45° FOV.
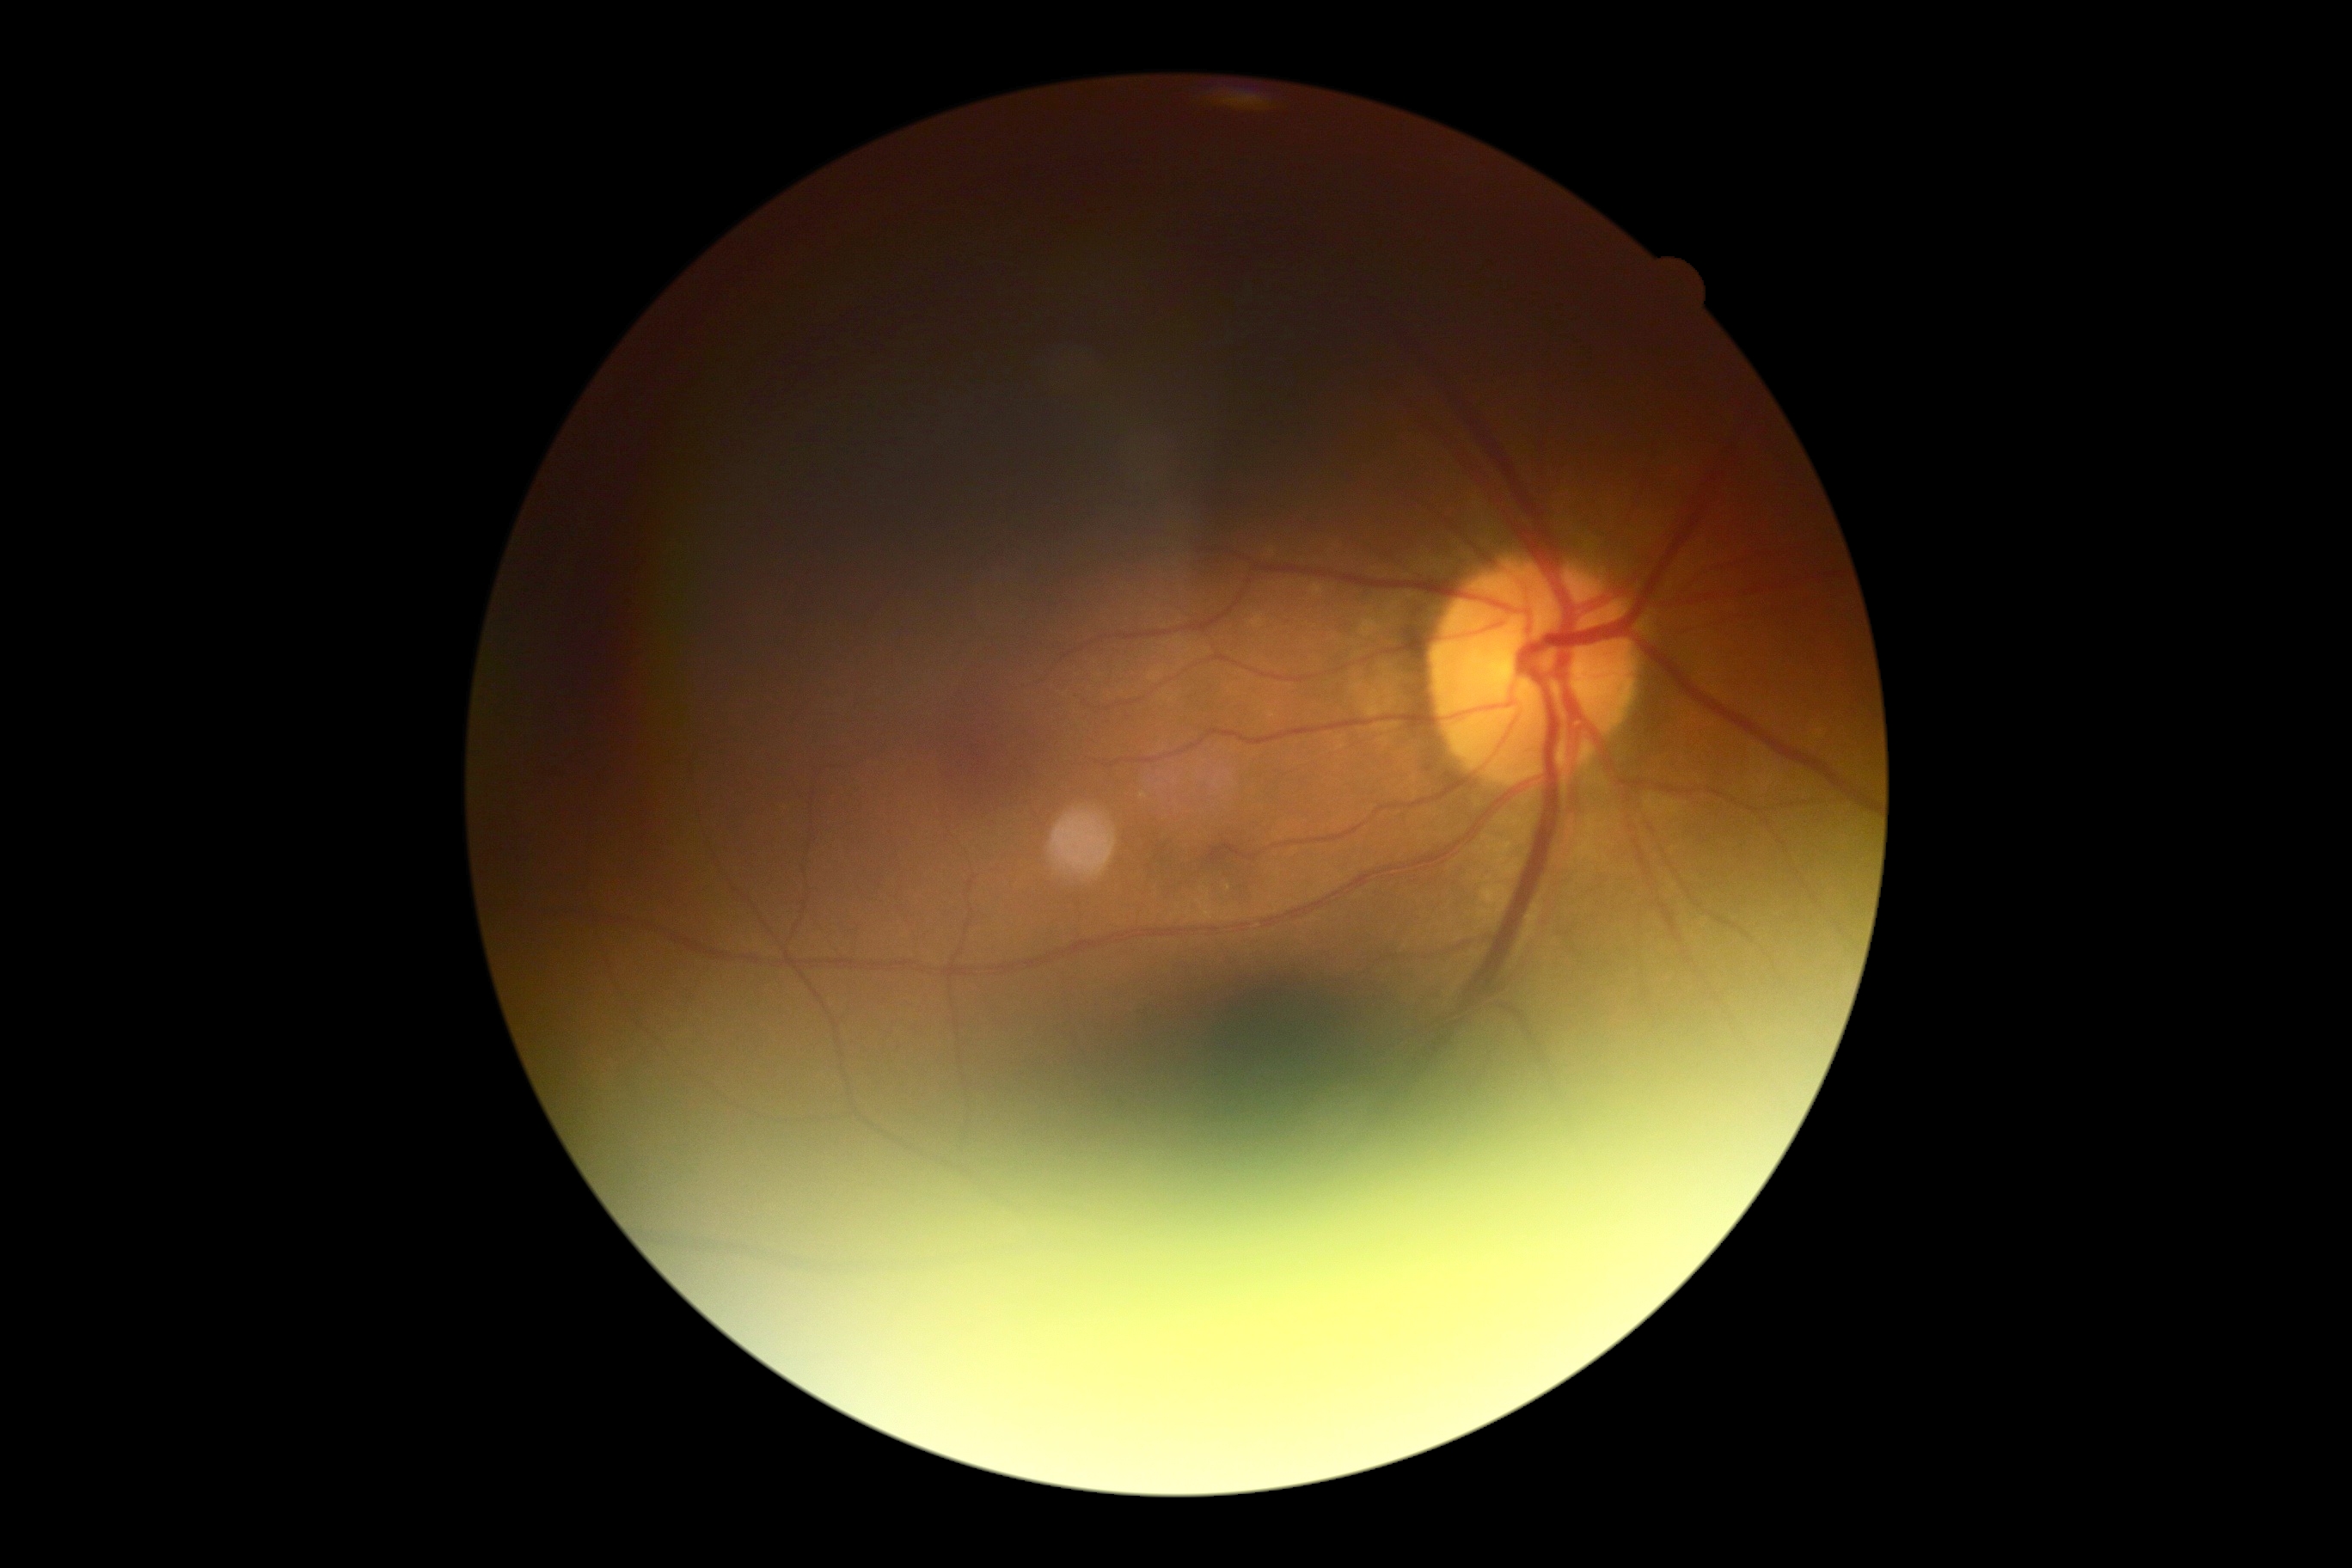

{
  "dr_grade": "grade 0 (no apparent retinopathy)"
}